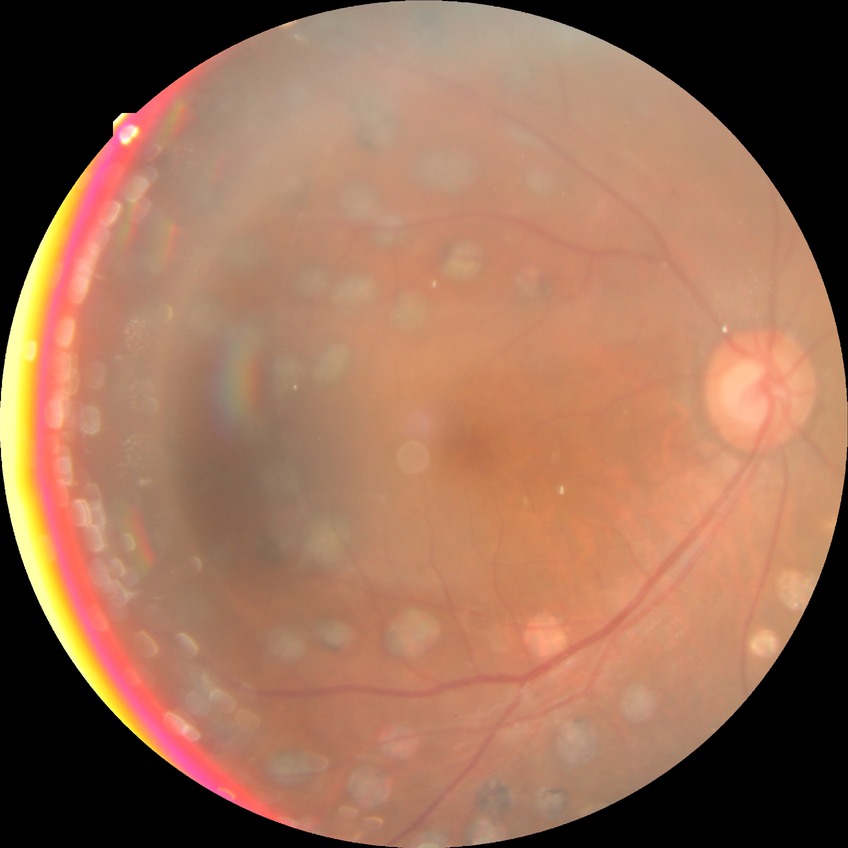
DR stage is PDR.